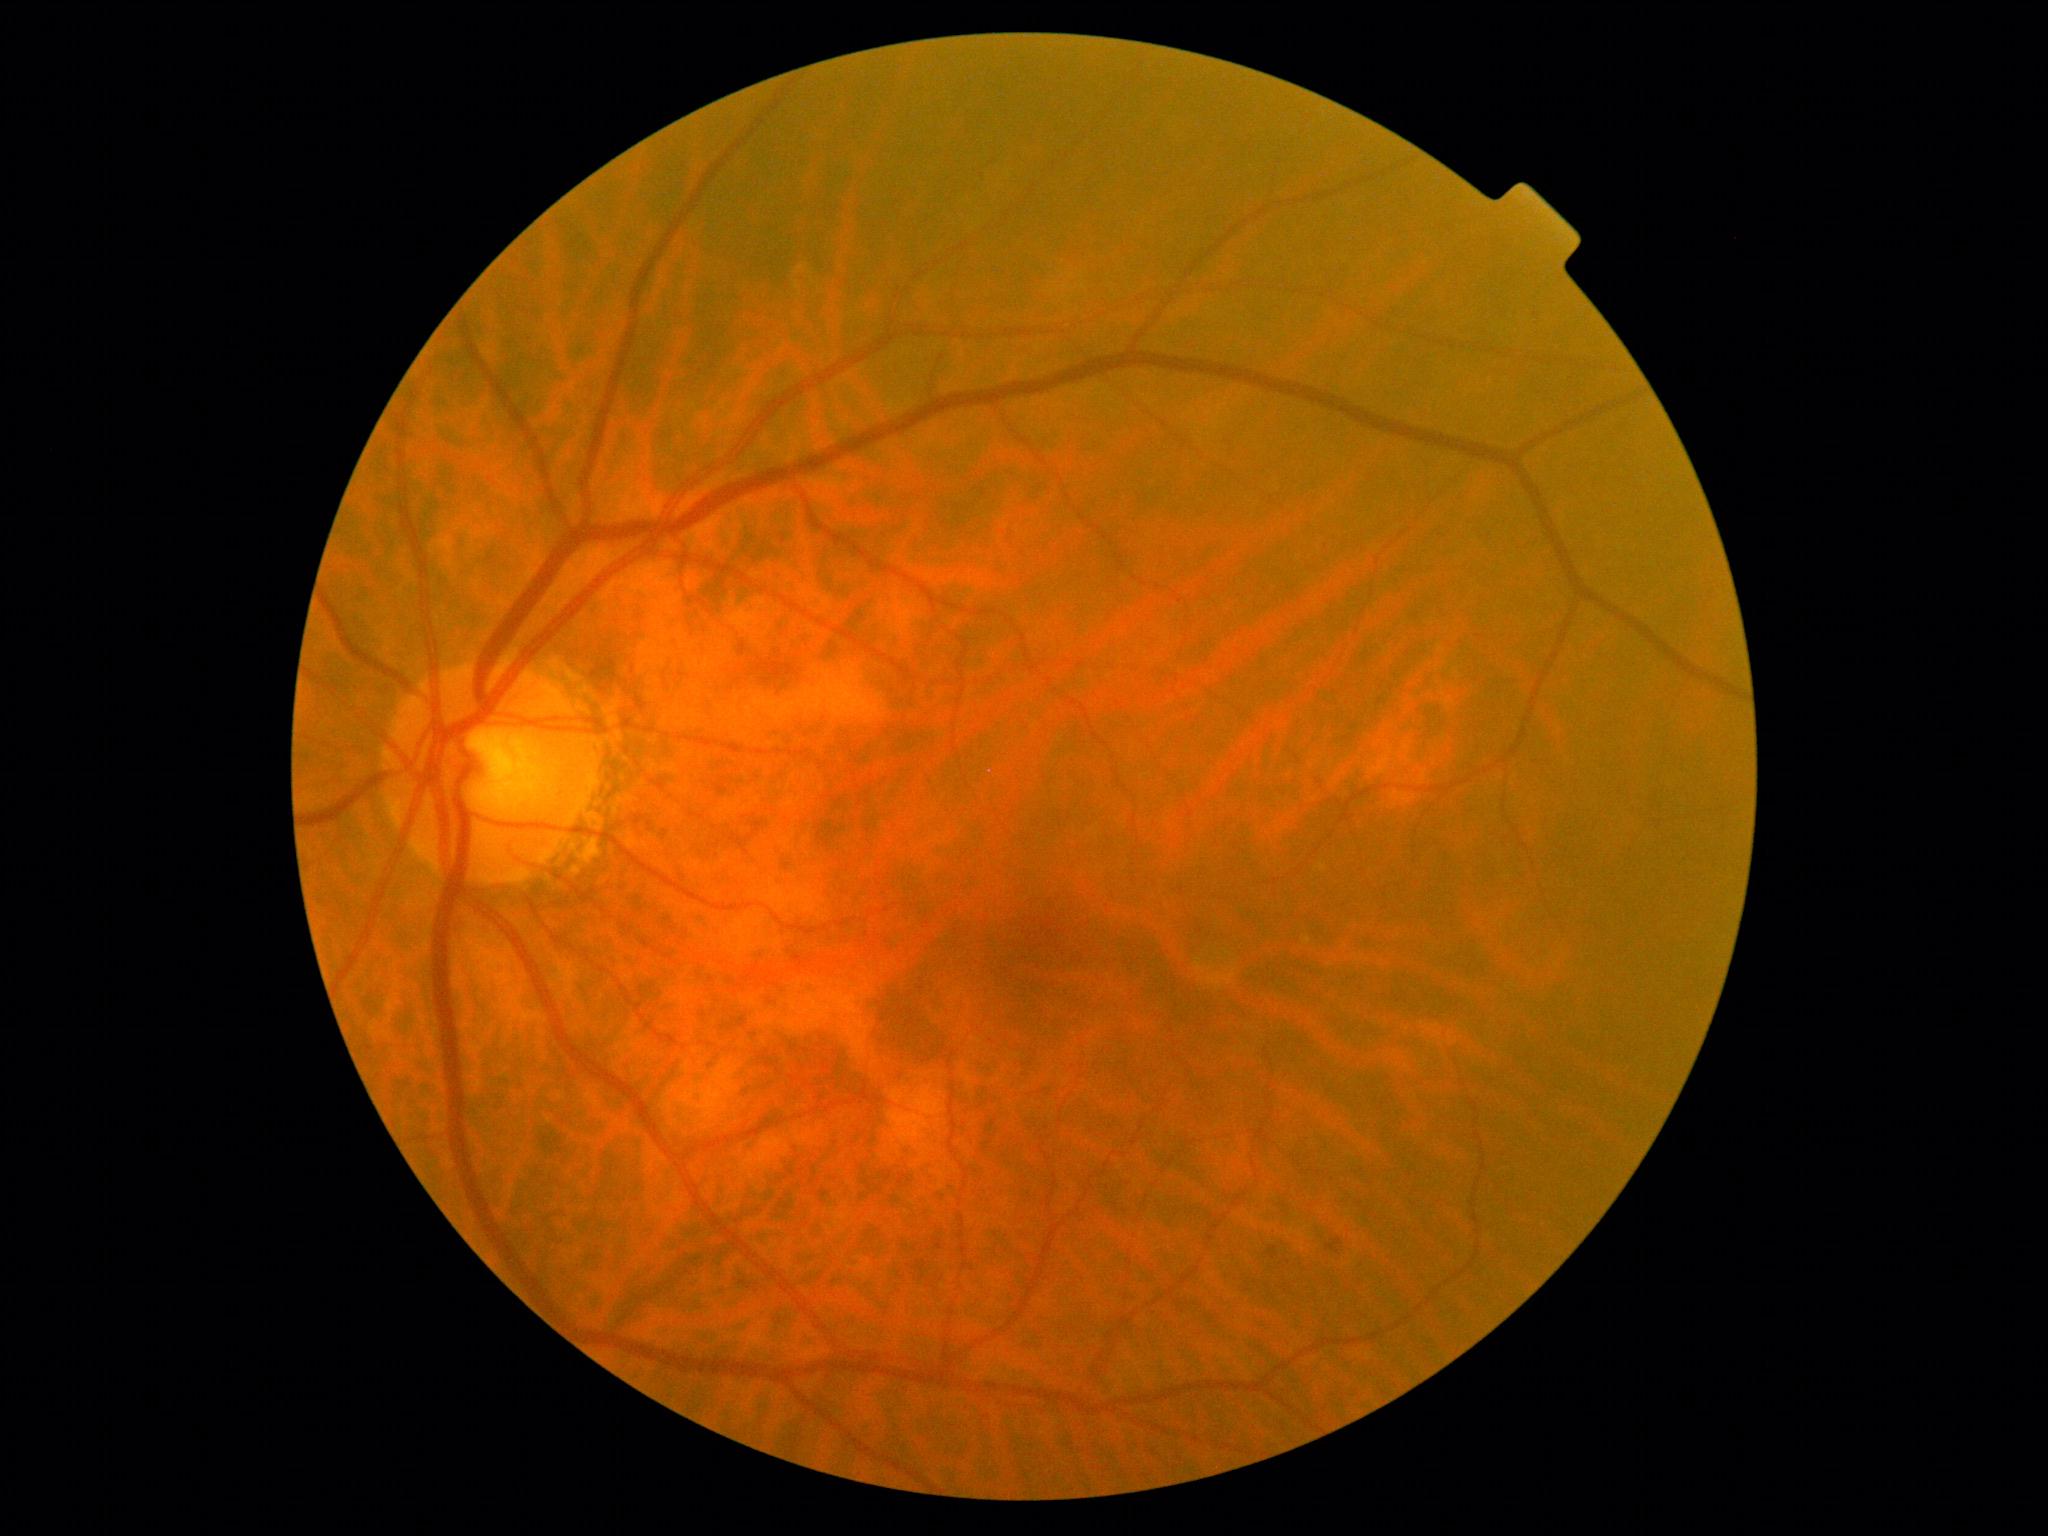
Retinopathy grade: 0 (no apparent retinopathy).